Wide-field contact fundus photograph of an infant: 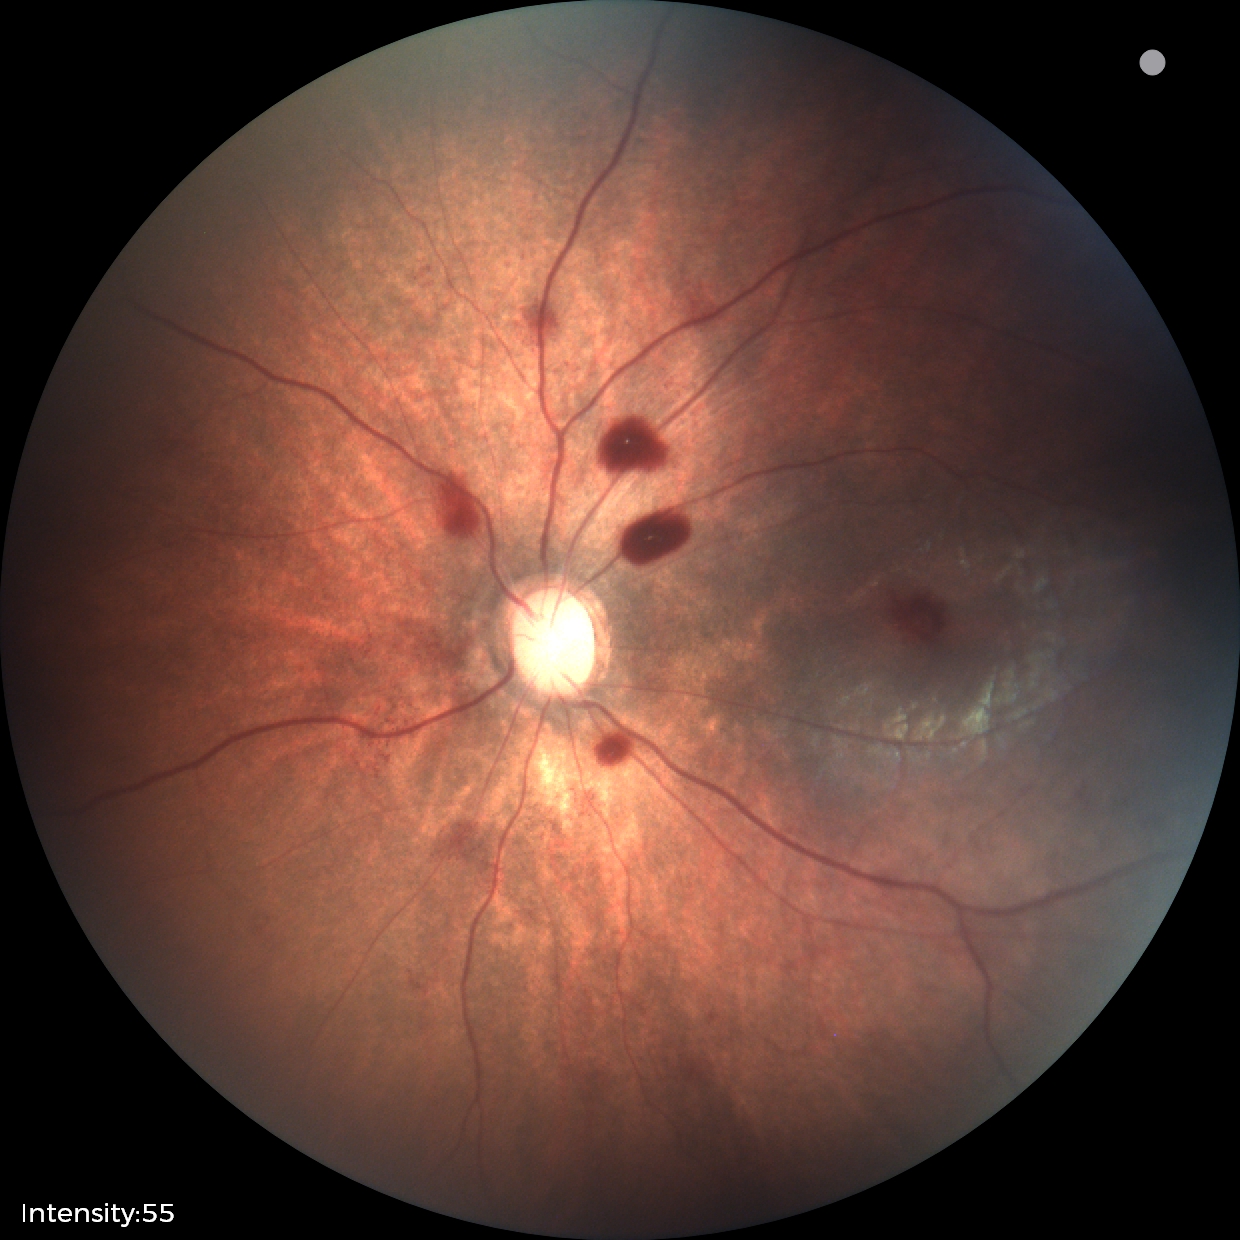

Assessment: retinal hemorrhages.